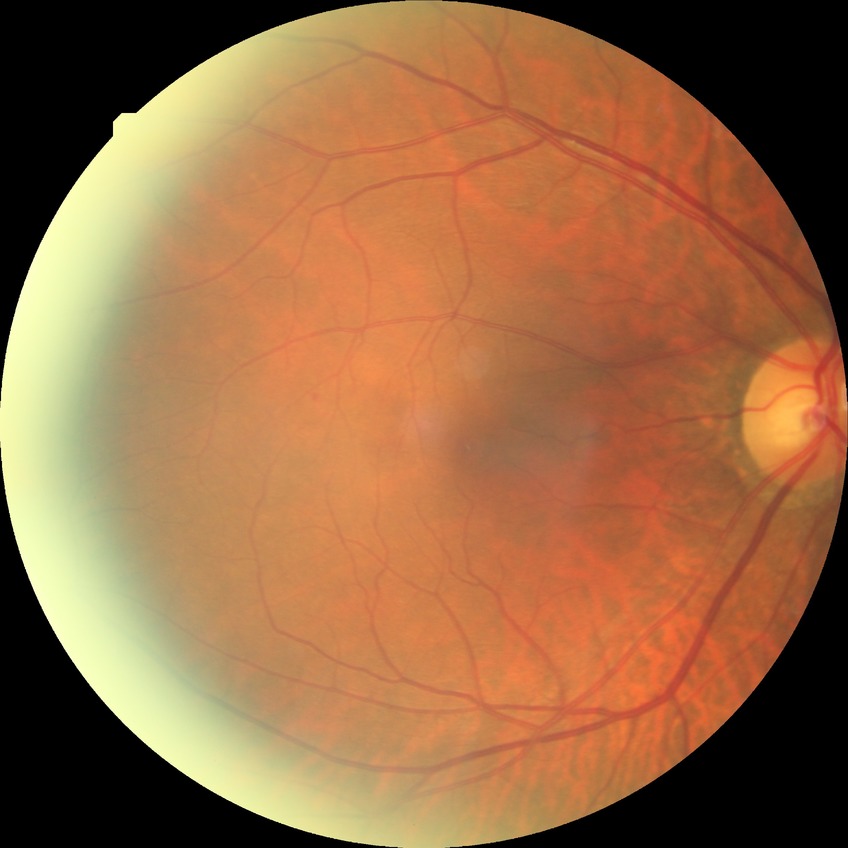
Diabetic retinopathy (DR) is simple diabetic retinopathy (SDR).